FOV: 45 degrees, graded on the modified Davis scale
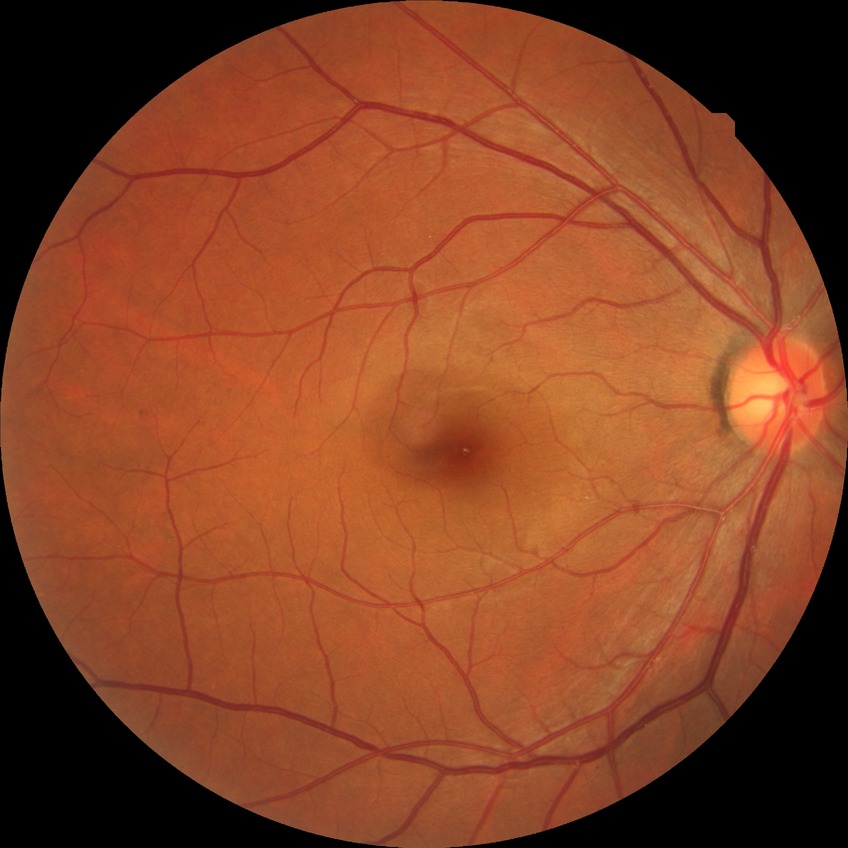
{"davis_grade": "no diabetic retinopathy"}